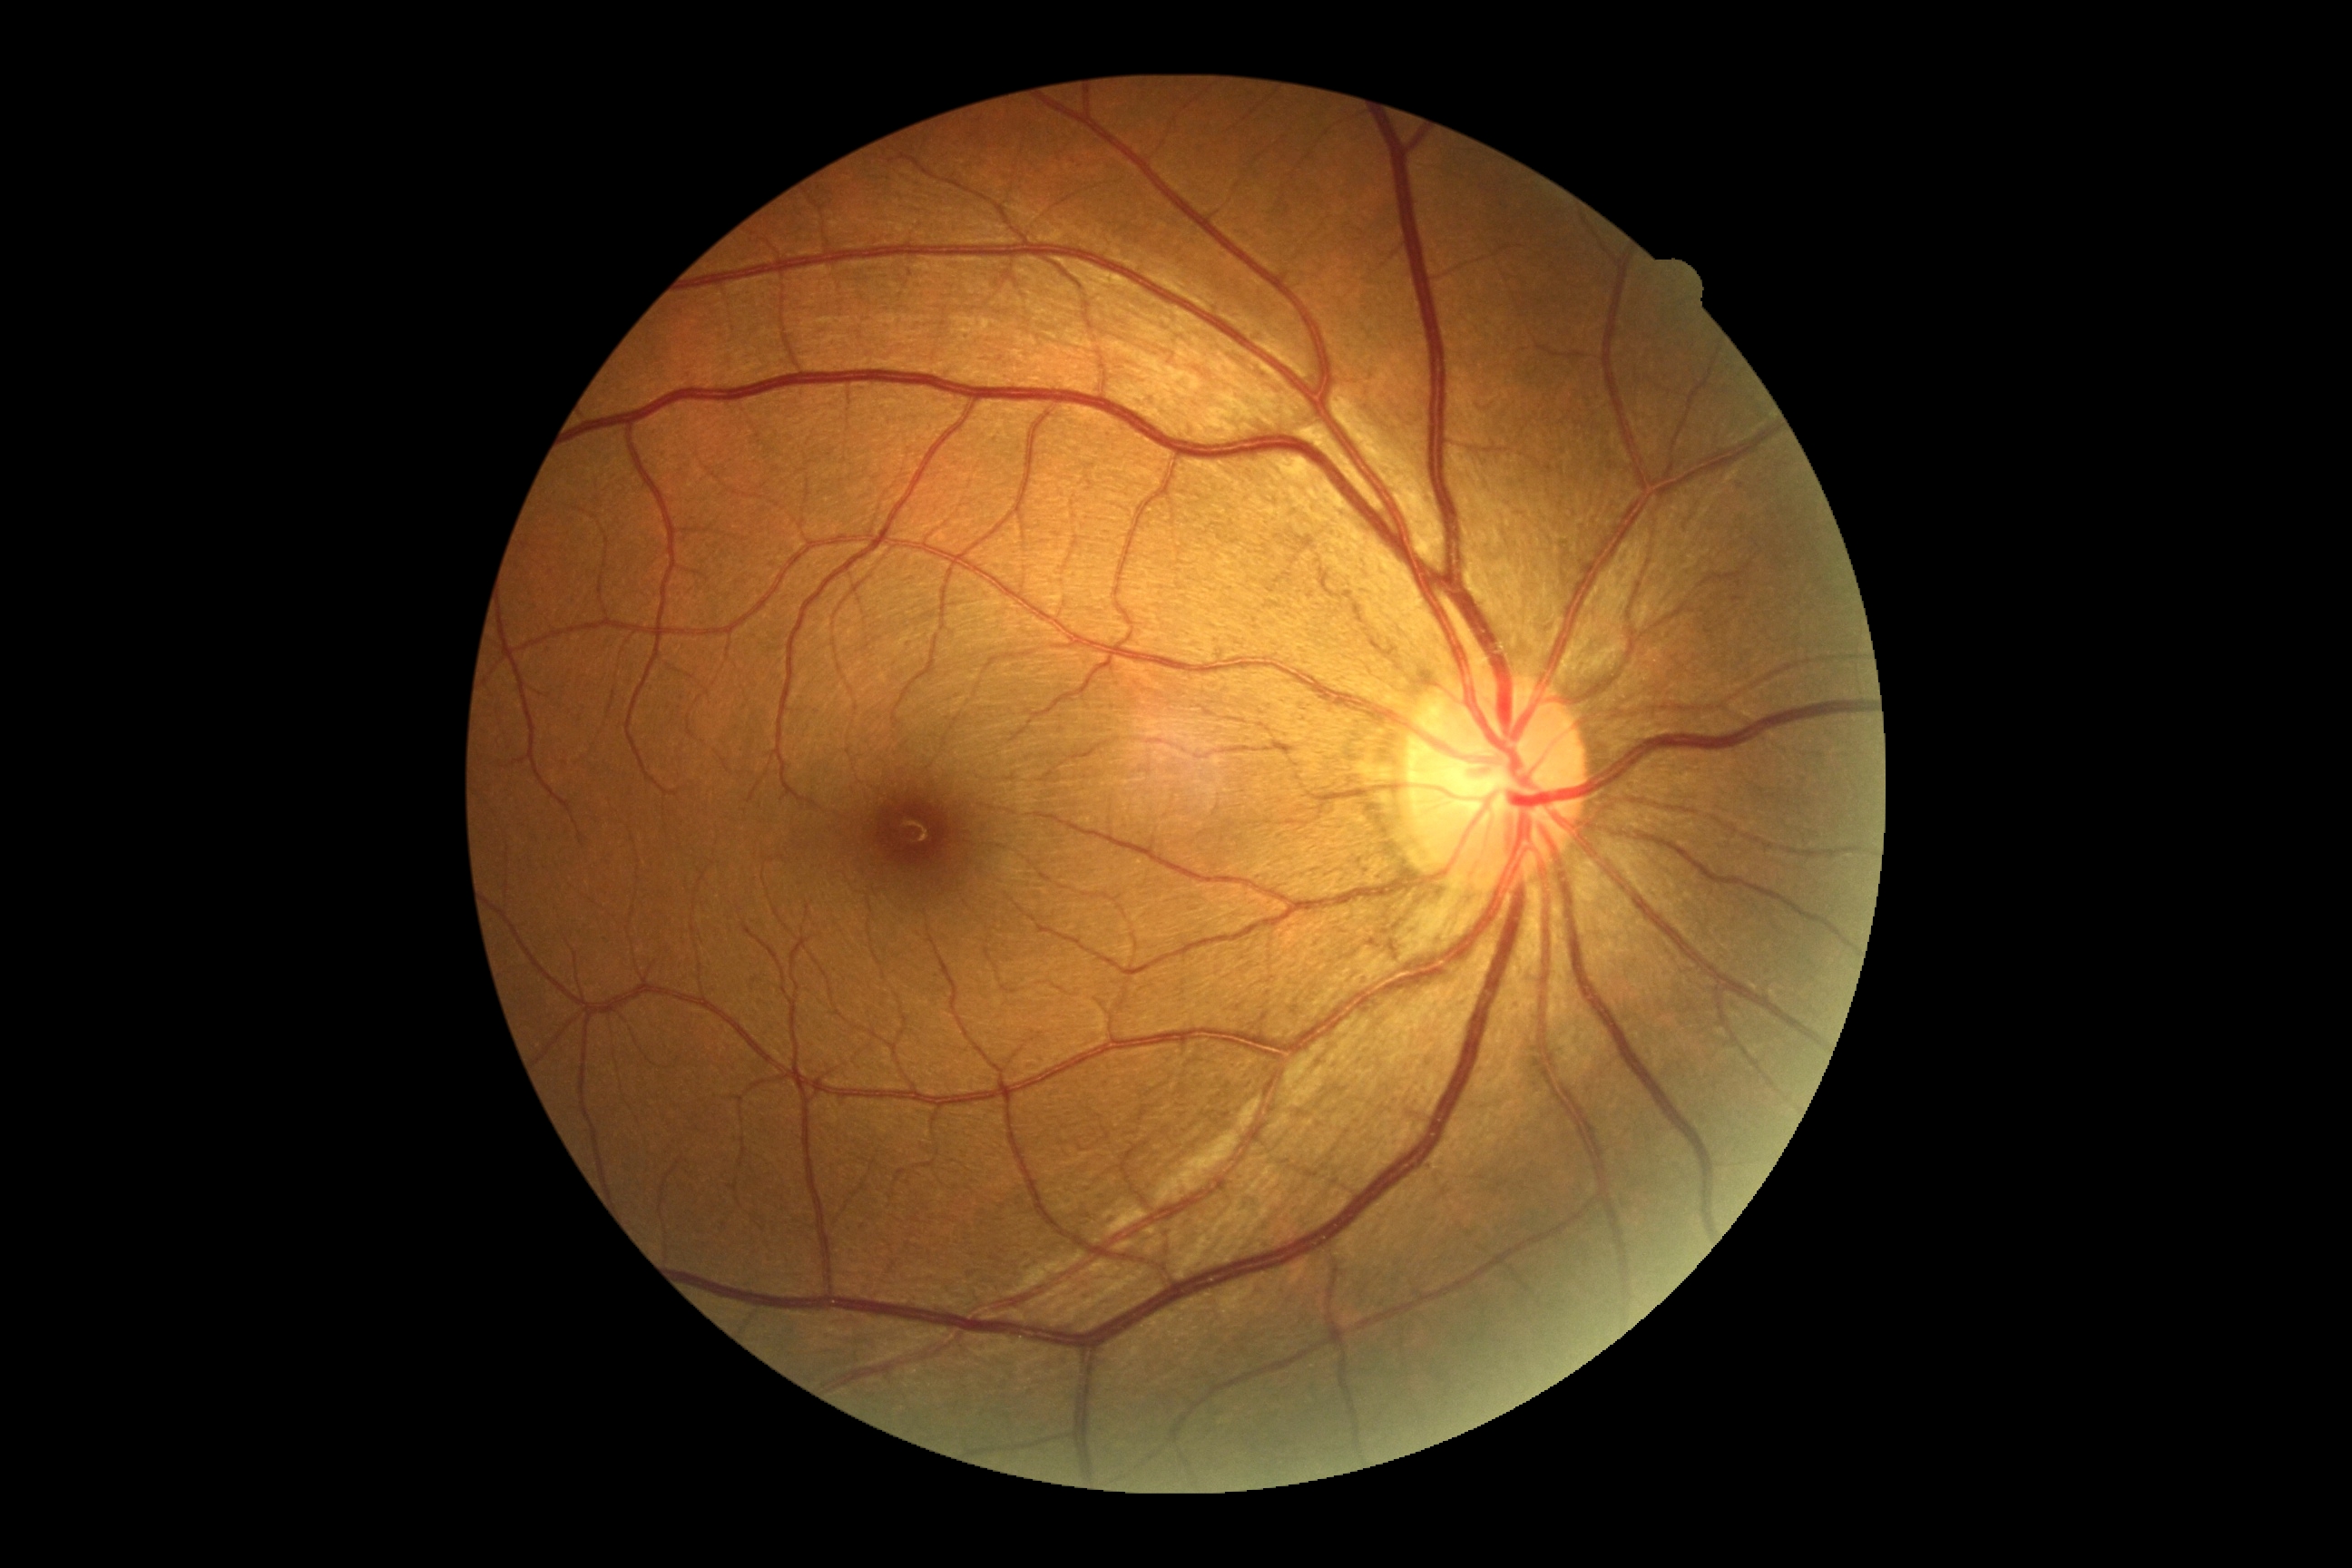 DR grade: 0 (no apparent retinopathy).